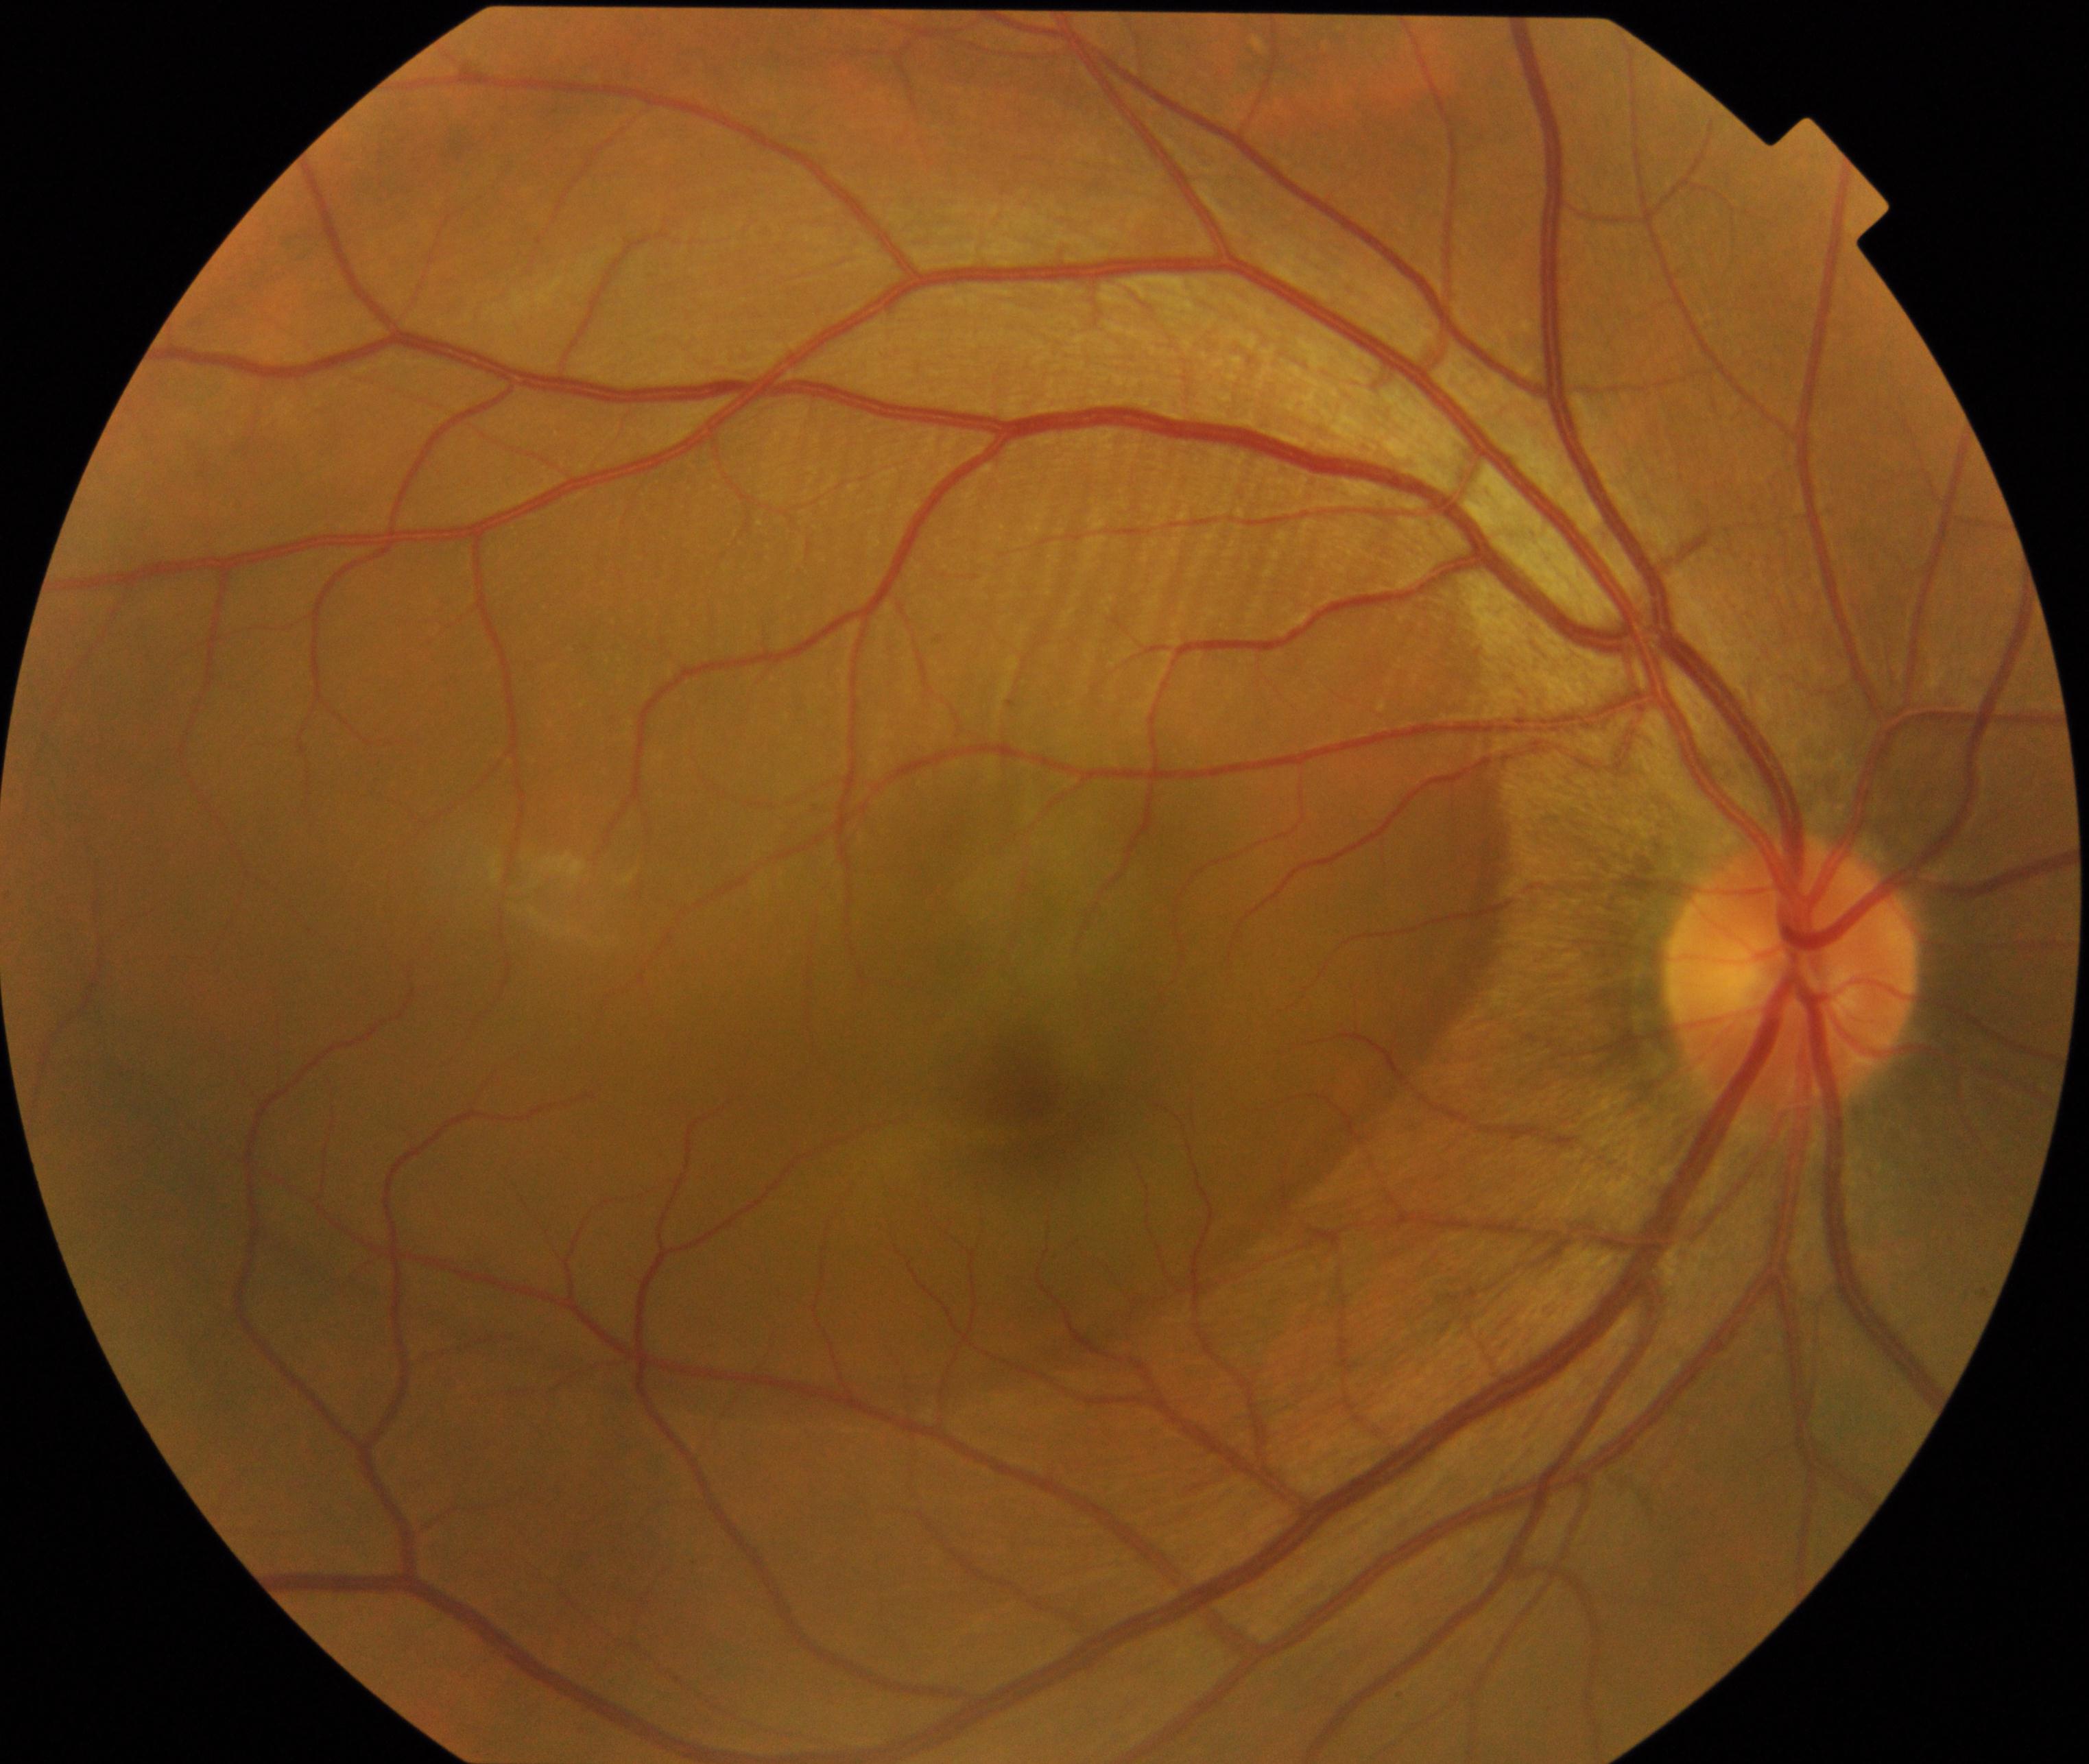

Primary finding: central serous chorioretinopathy.